Color fundus photograph:
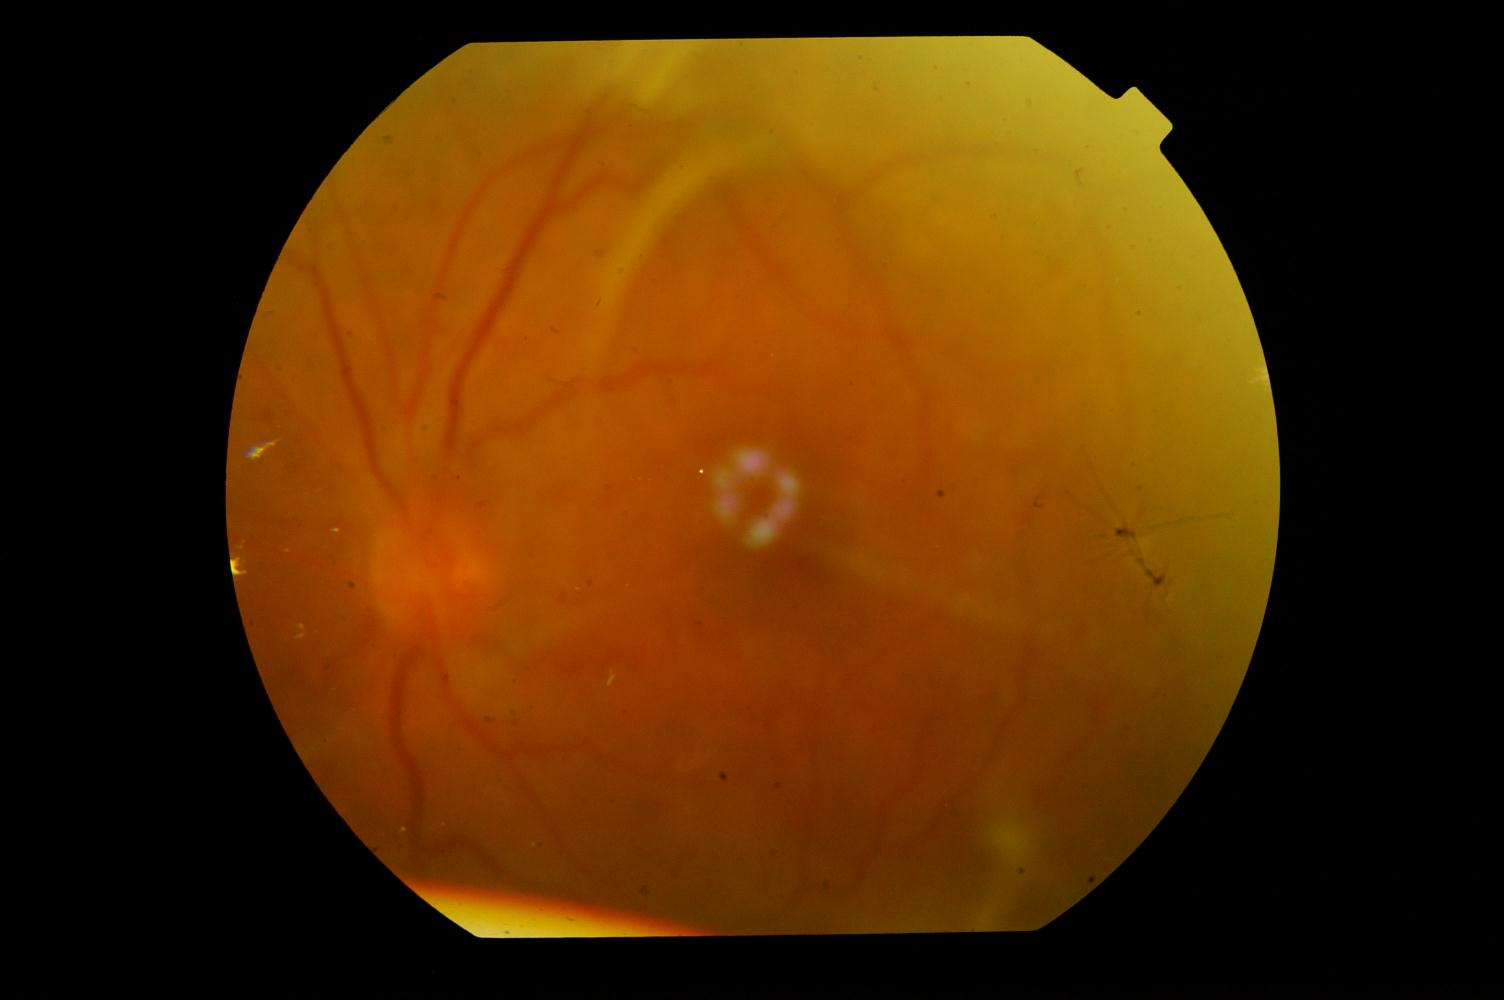
Impression: diabetic retinopathy.